45-degree field of view. CFP. Image size 1536x1152
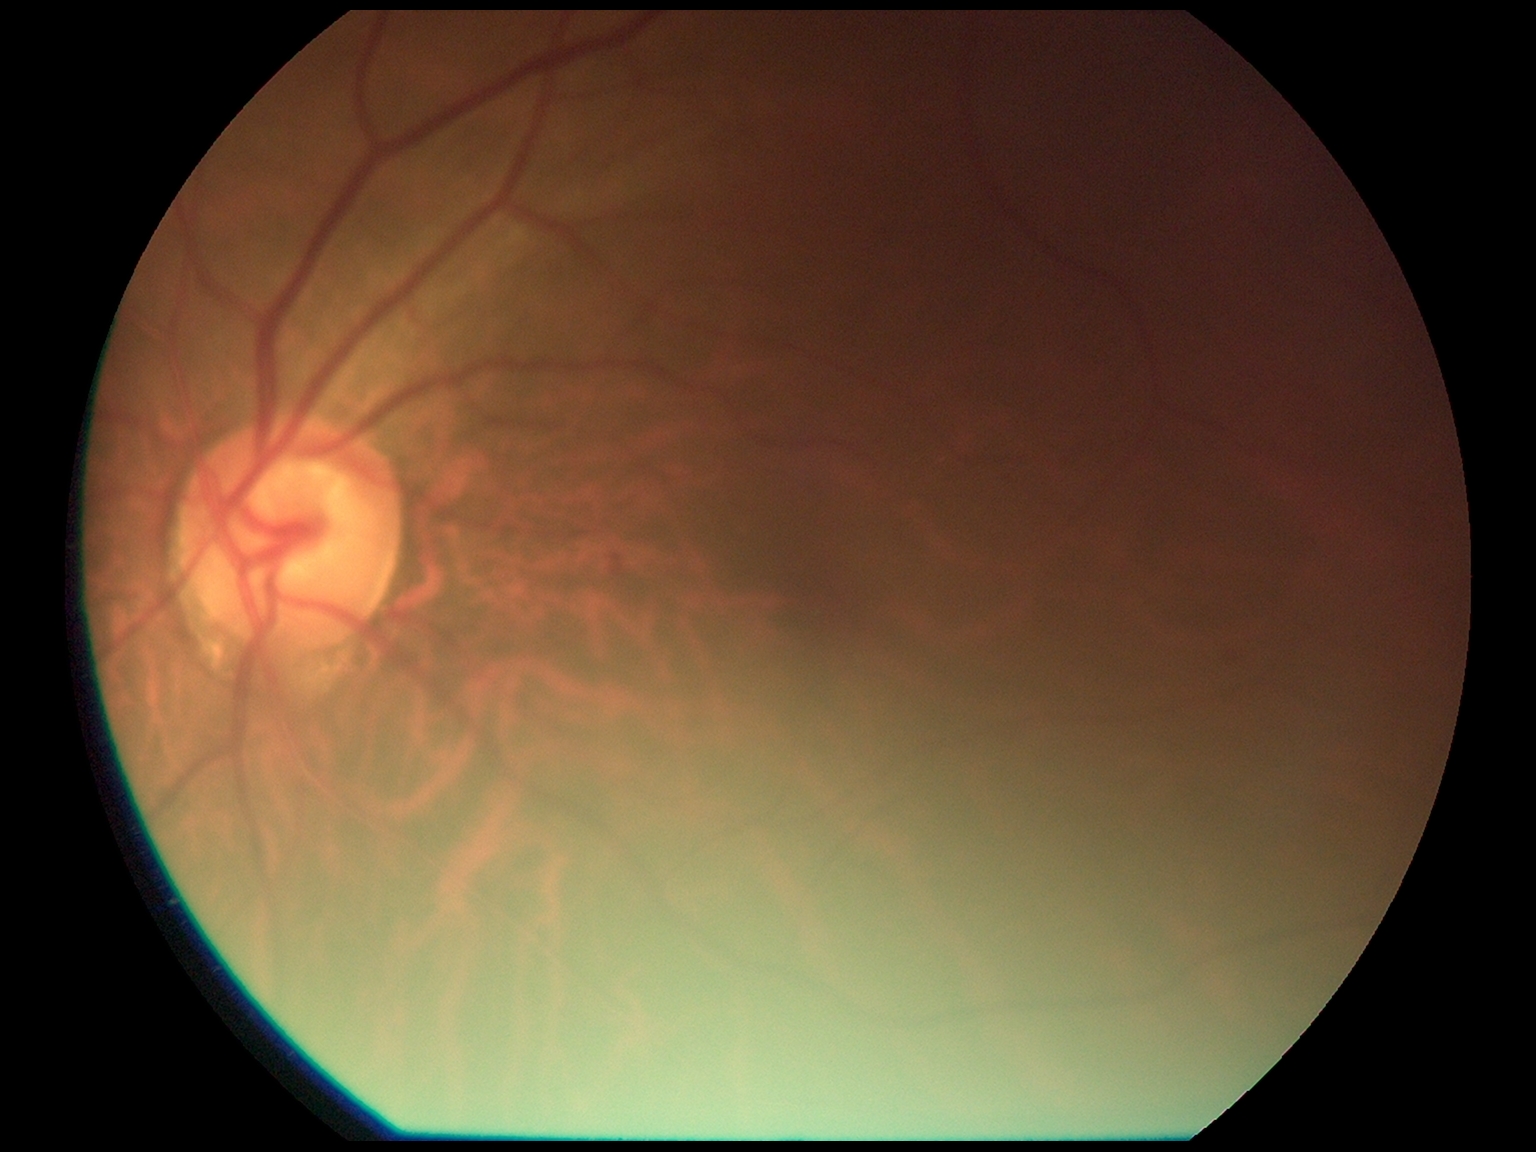 Diabetic retinopathy is grade 2.